848x848px · without pupil dilation:
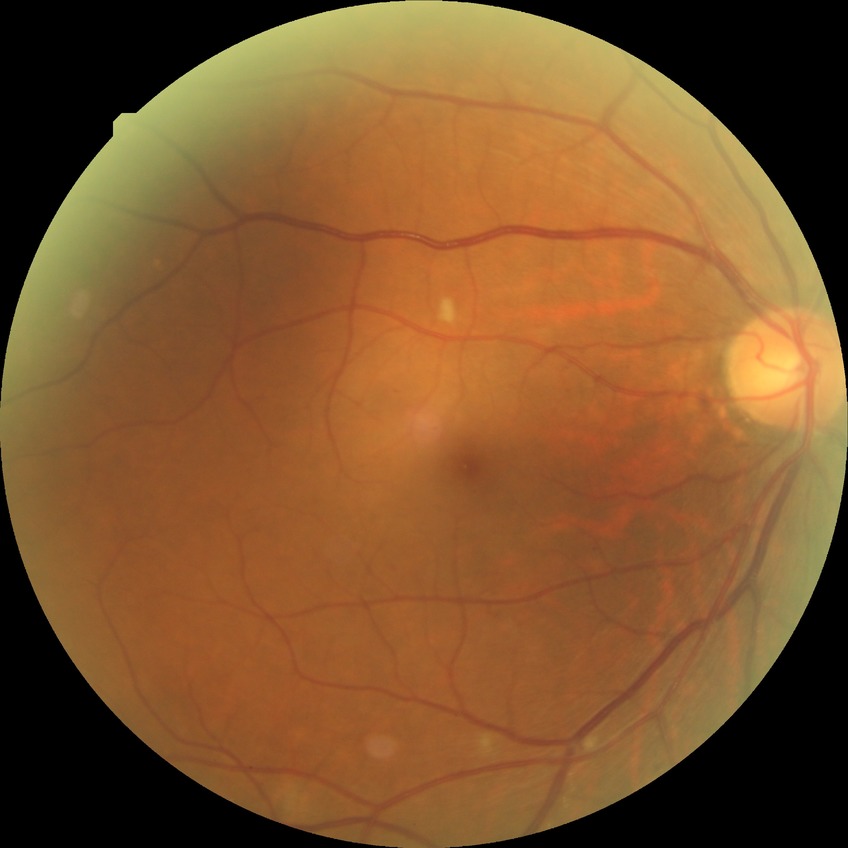 retinopathy grade: simple diabetic retinopathy.